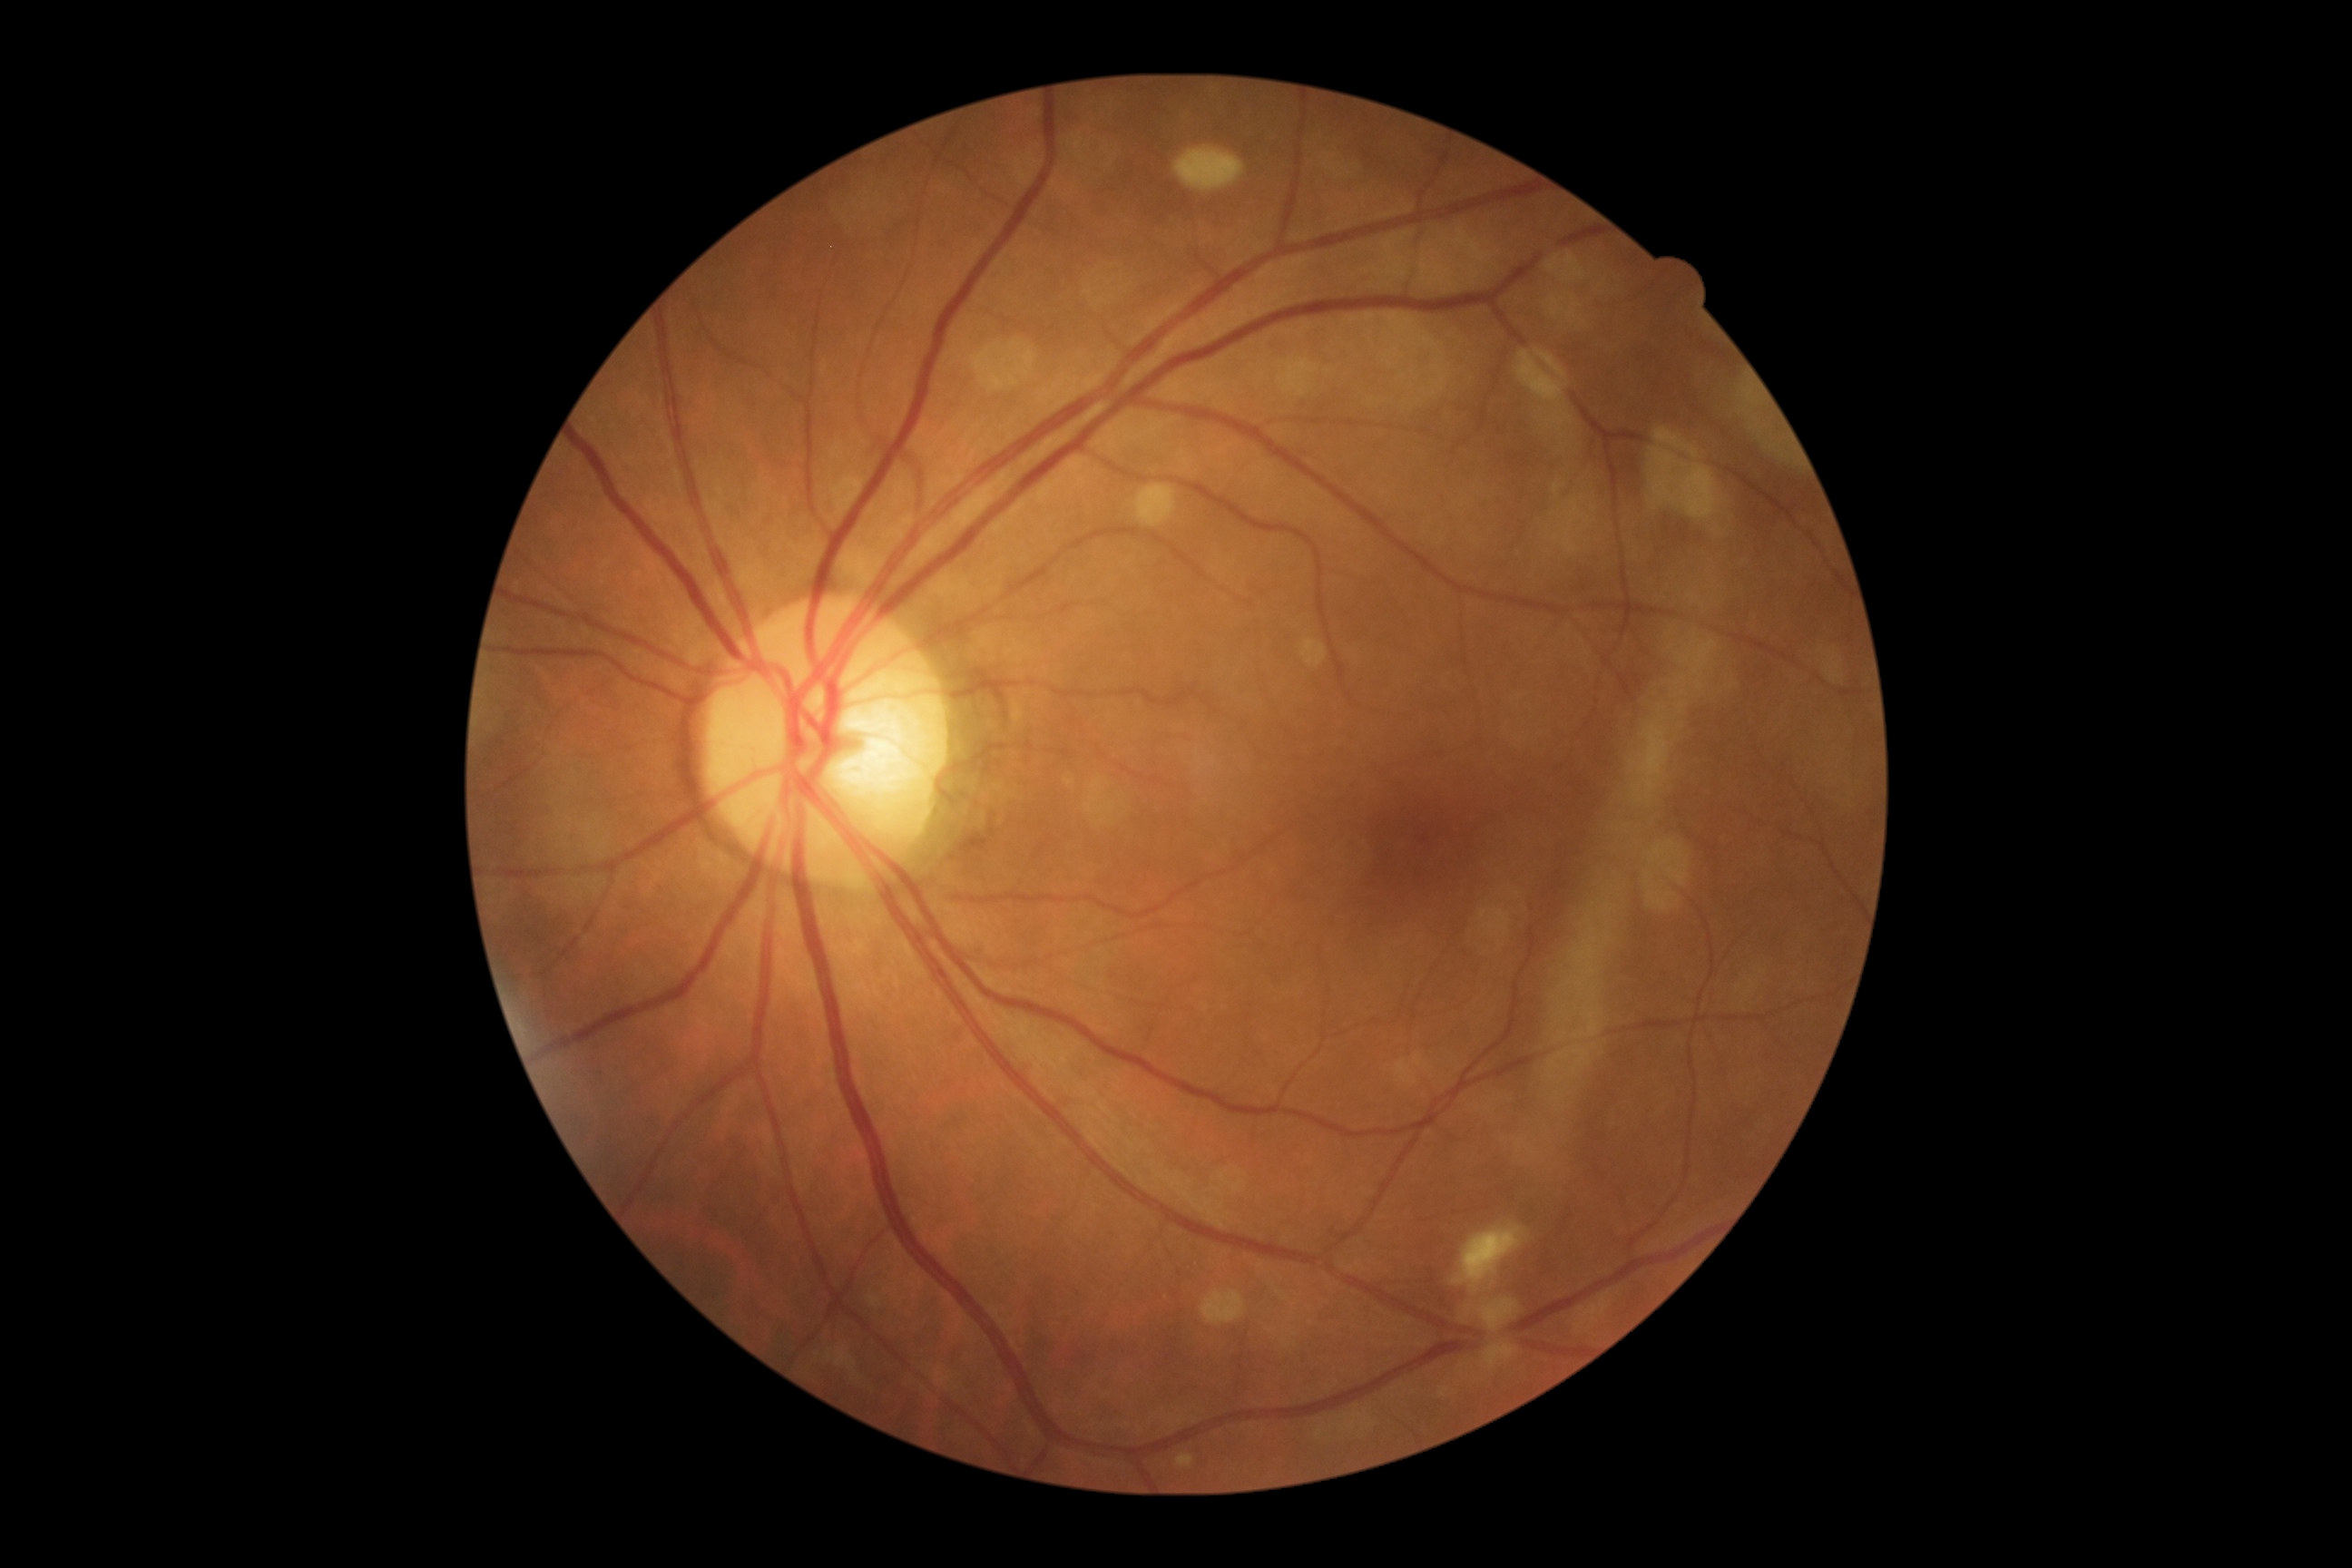
* DR class: non-proliferative diabetic retinopathy
* diabetic retinopathy (DR): grade 2